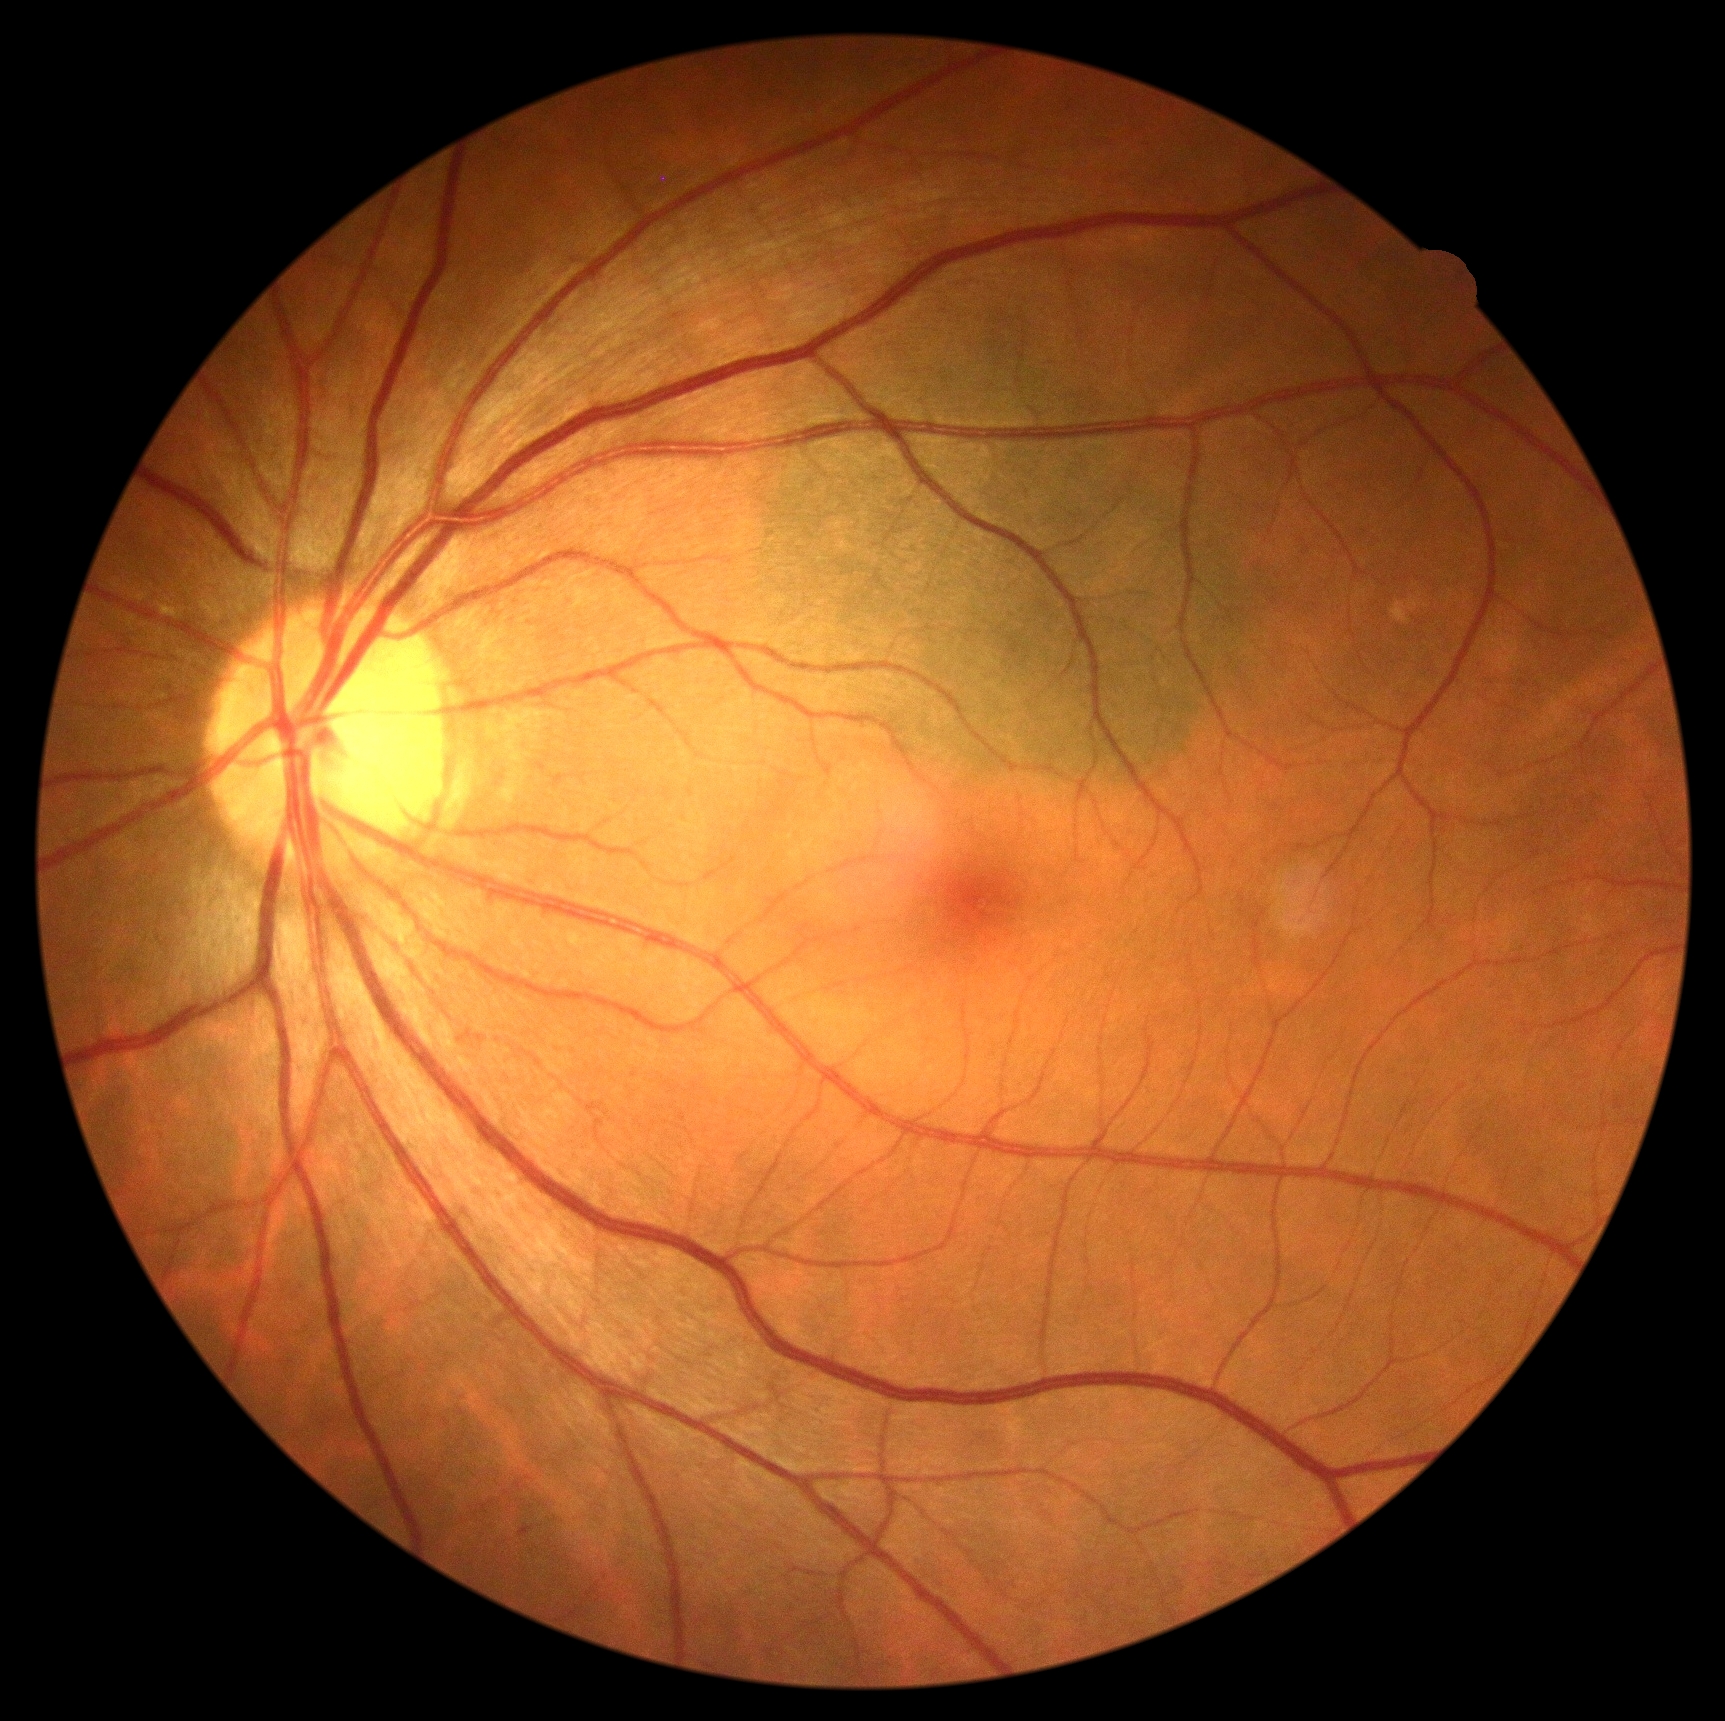 Diabetic retinopathy (DR): grade 0 (no apparent retinopathy).